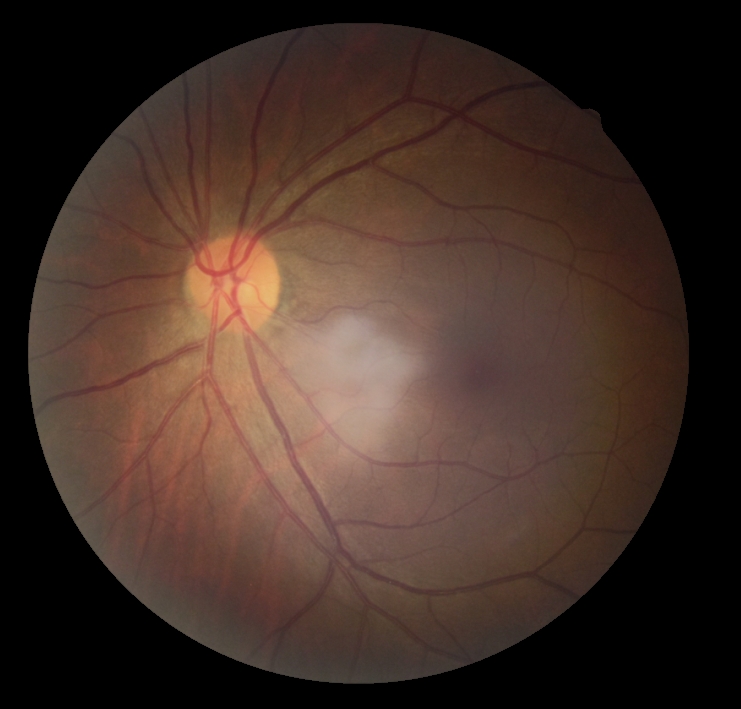
DR grade is no apparent diabetic retinopathy (0) — no visible signs of diabetic retinopathy.